Wide-field fundus photograph from neonatal ROP screening; 640x480; acquired on the Clarity RetCam 3 — 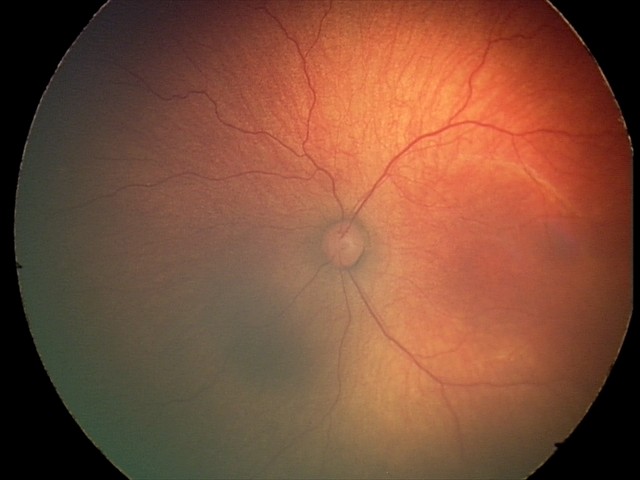

Impression = ROP stage 2; plus disease = absent.